Posterior pole color fundus photograph; without pupil dilation; diabetic retinopathy graded by the modified Davis classification; 848x848:
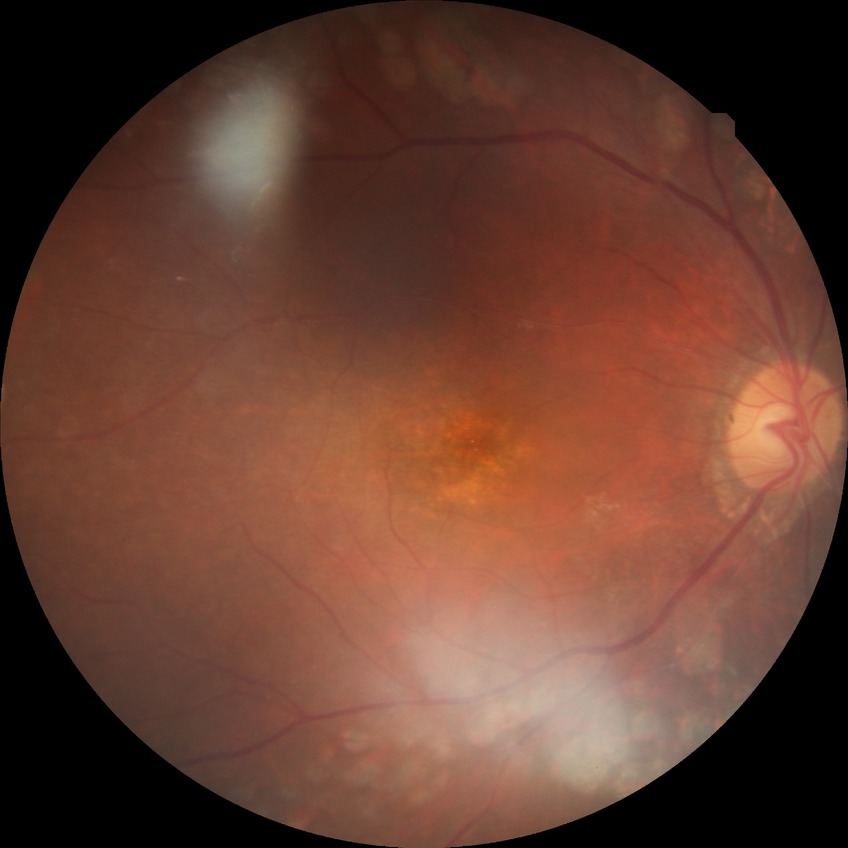 diabetic retinopathy (DR) = PDR (proliferative diabetic retinopathy).